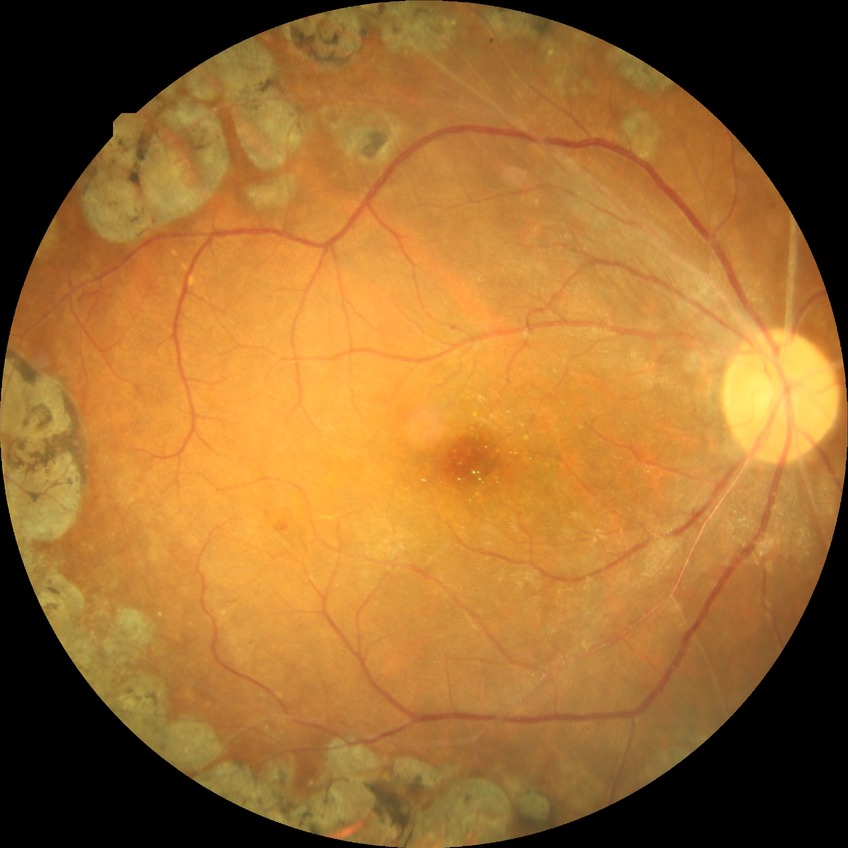
Diabetic retinopathy grade: proliferative diabetic retinopathy.